Wide-field fundus photograph of an infant. 640x480 — 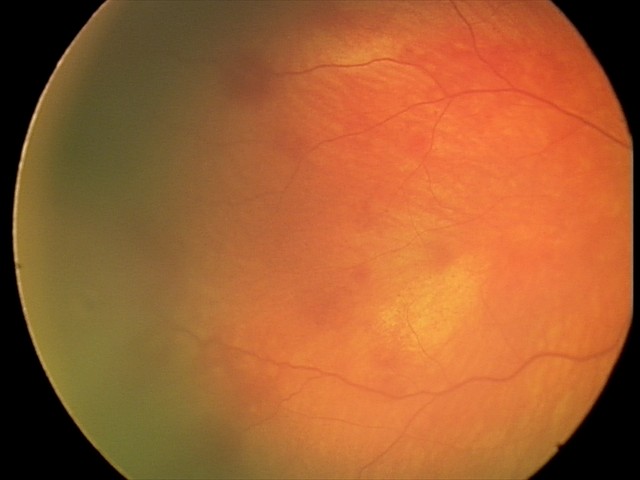

Normal screening examination.